CFP · FOV: 45 degrees:
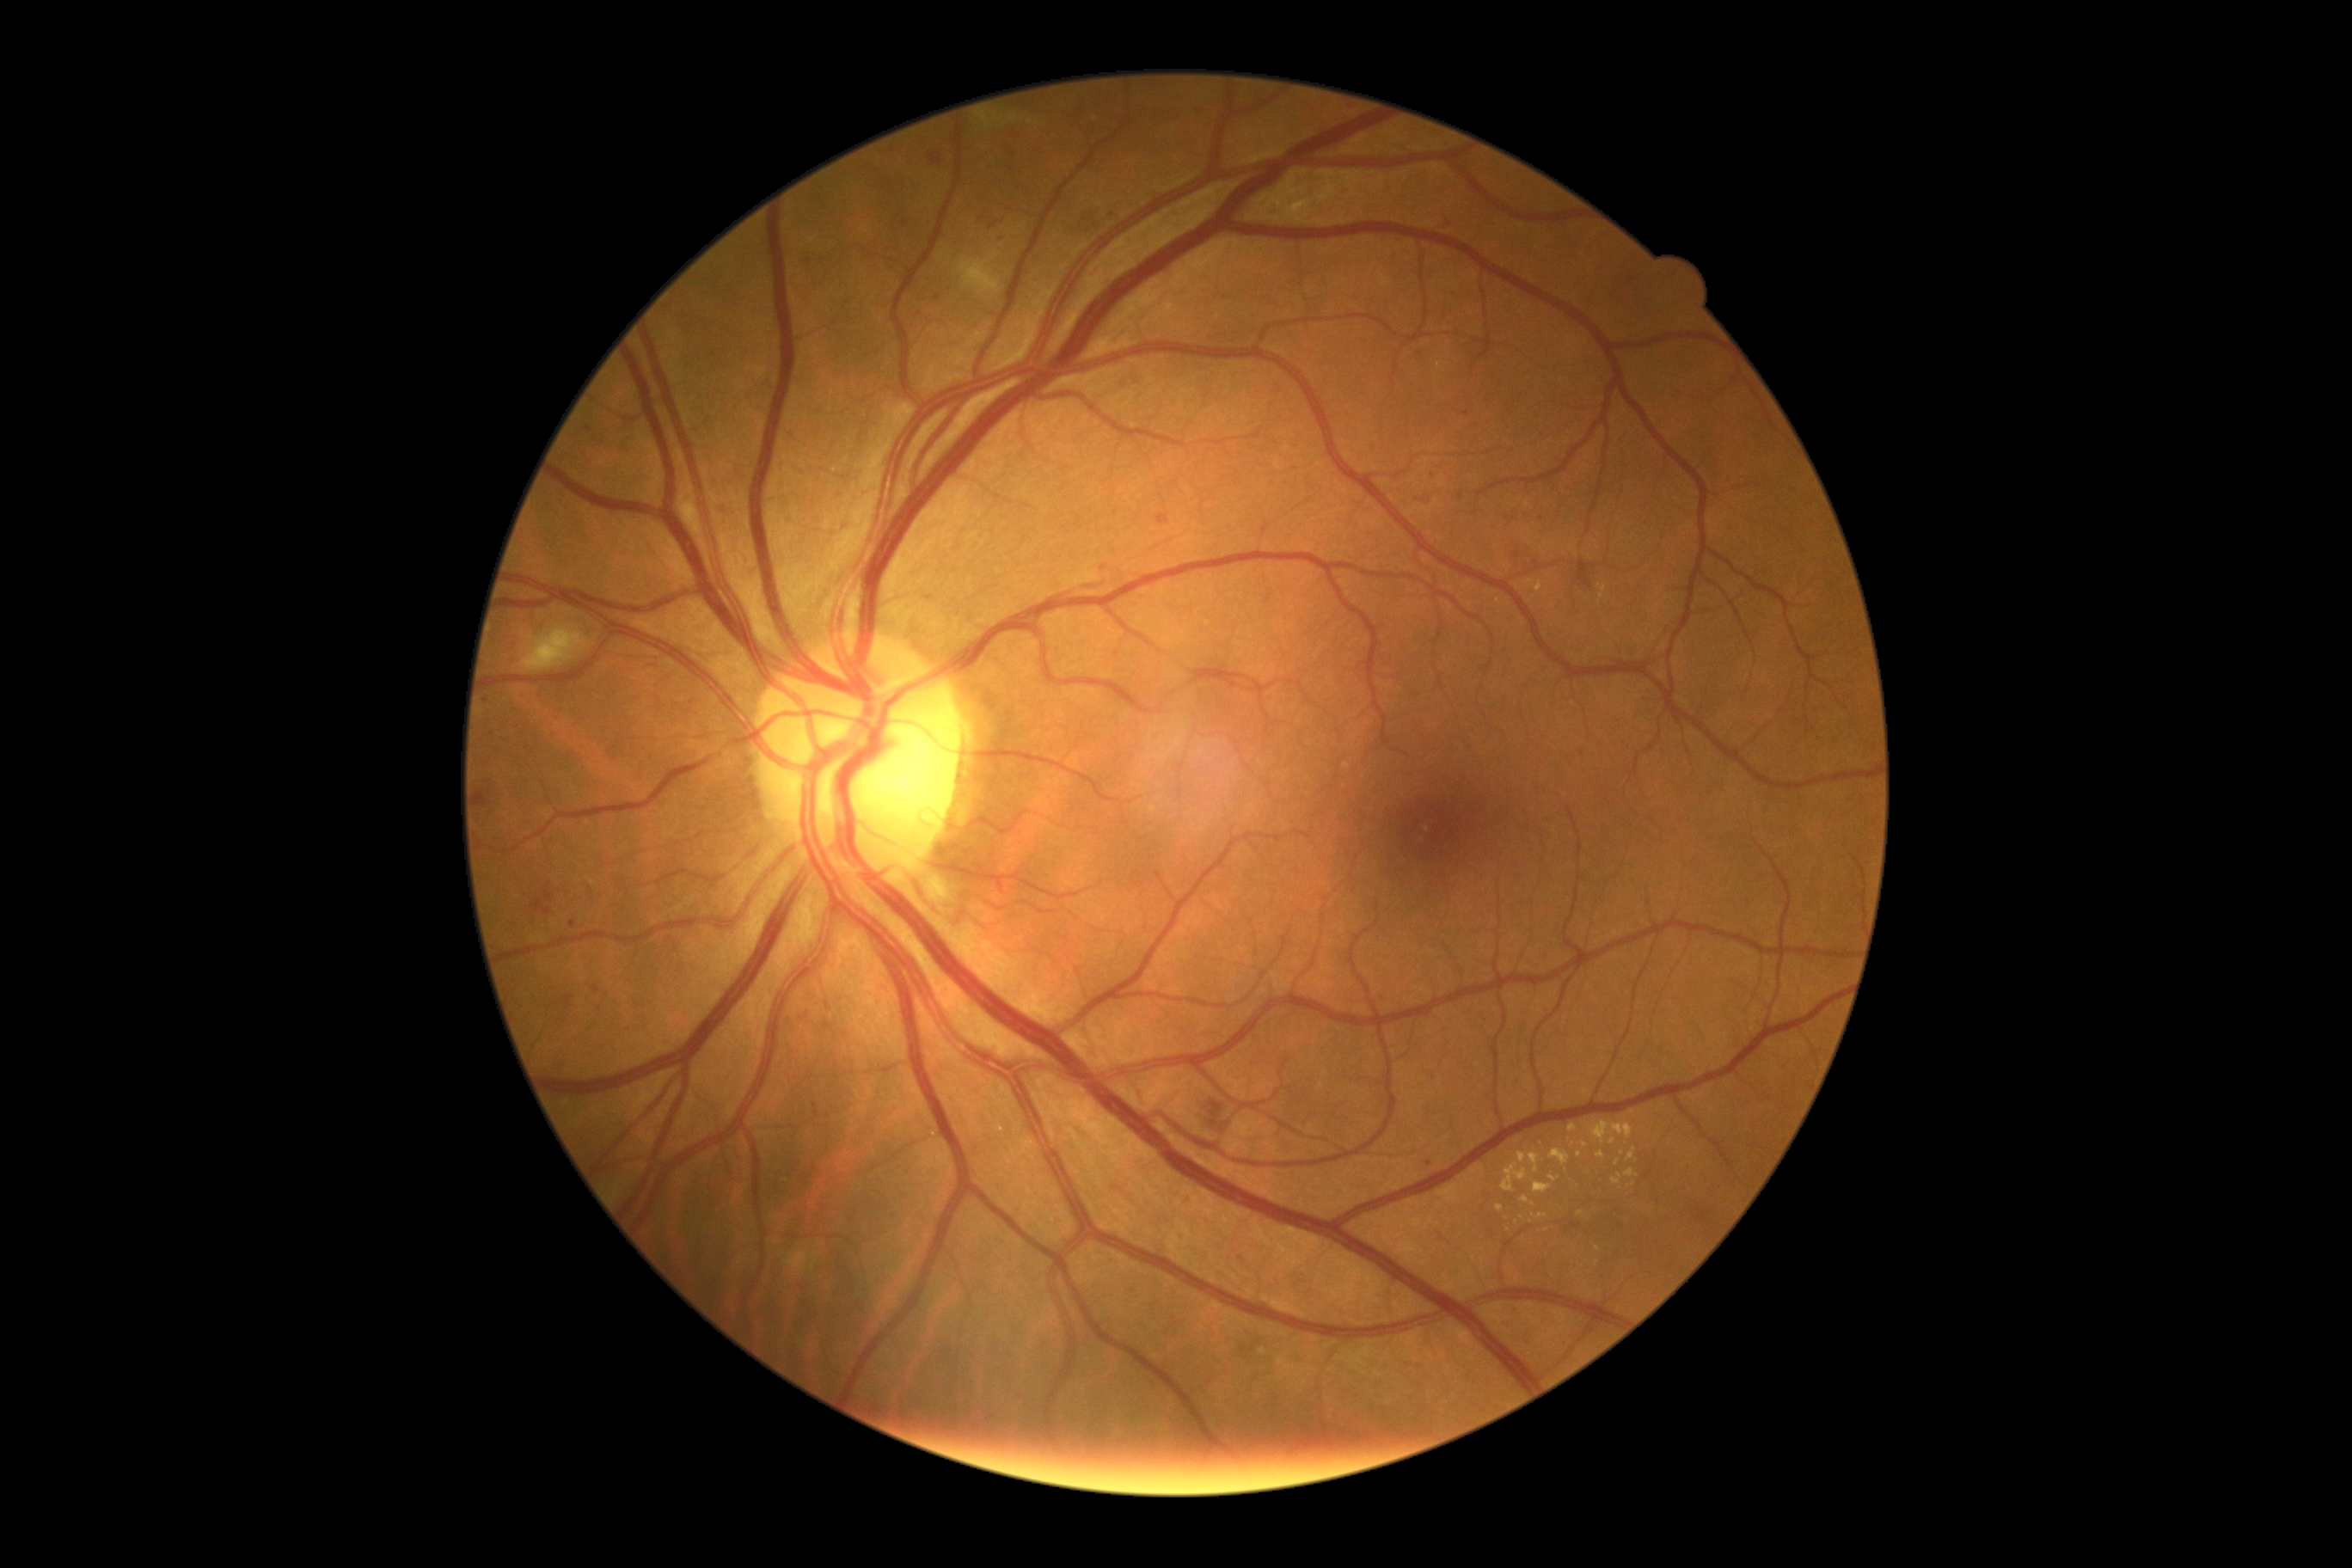

DR stage: moderate NPDR (grade 2) — more than just microaneurysms but less than severe NPDR.
MAs include those at 1504, 1326, 1514, 1333 | 814, 1103, 819, 1120 | 1698, 1216, 1706, 1223 | 585, 426, 594, 432 | 718, 505, 732, 515 | 989, 221, 998, 230 | 1565, 1223, 1581, 1230 | 563, 996, 575, 1010 | 542, 885, 556, 902.
MAs (small, approximate centers) near (492, 735) | (937, 299) | (1240, 1259) | (1582, 754) | (1187, 1202) | (1515, 1311) | (1420, 354) | (1709, 1212) | (1465, 415) | (527, 747).
EXs include those at 1612, 1173, 1622, 1185 | 1569, 1124, 1577, 1132 | 1534, 1182, 1552, 1194 | 1538, 1215, 1547, 1220 | 1626, 1170, 1638, 1179 | 1521, 1196, 1529, 1203 | 1502, 1165, 1528, 1194 | 1536, 582, 1543, 592 | 1550, 1149, 1571, 1165.
EXs (small, approximate centers) near (1622, 1154) | (1580, 1213) | (1585, 1145) | (1522, 1218) | (1597, 1263).